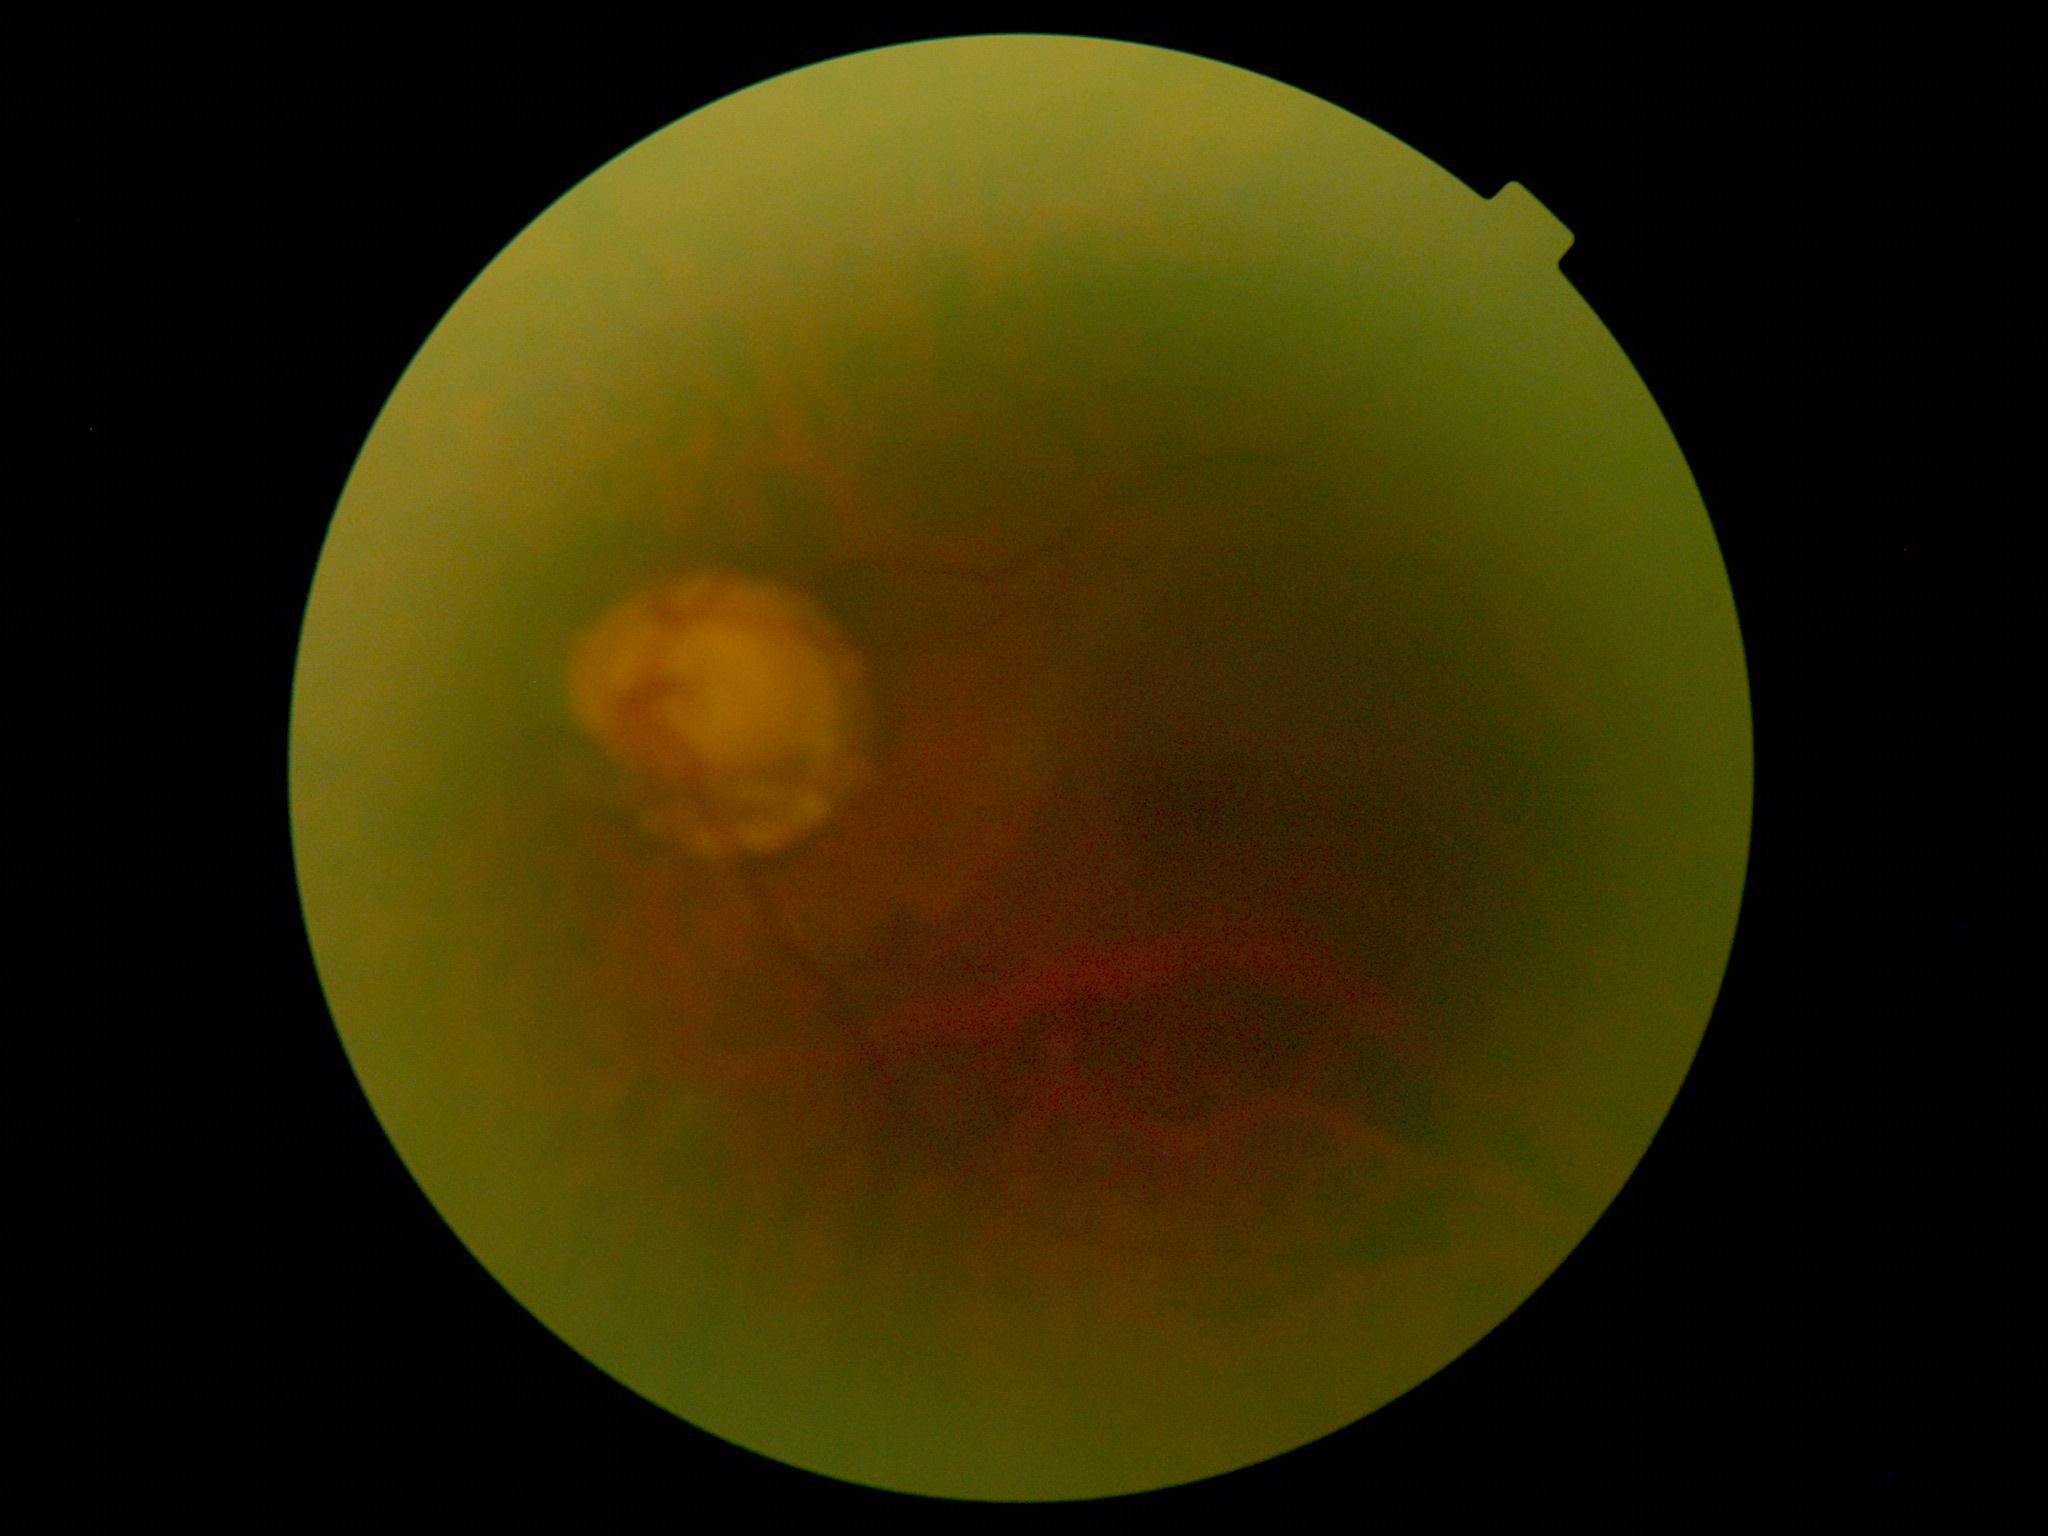 diabetic retinopathy (DR): grade 0 (no apparent retinopathy).